CFP · 2352x1568px.
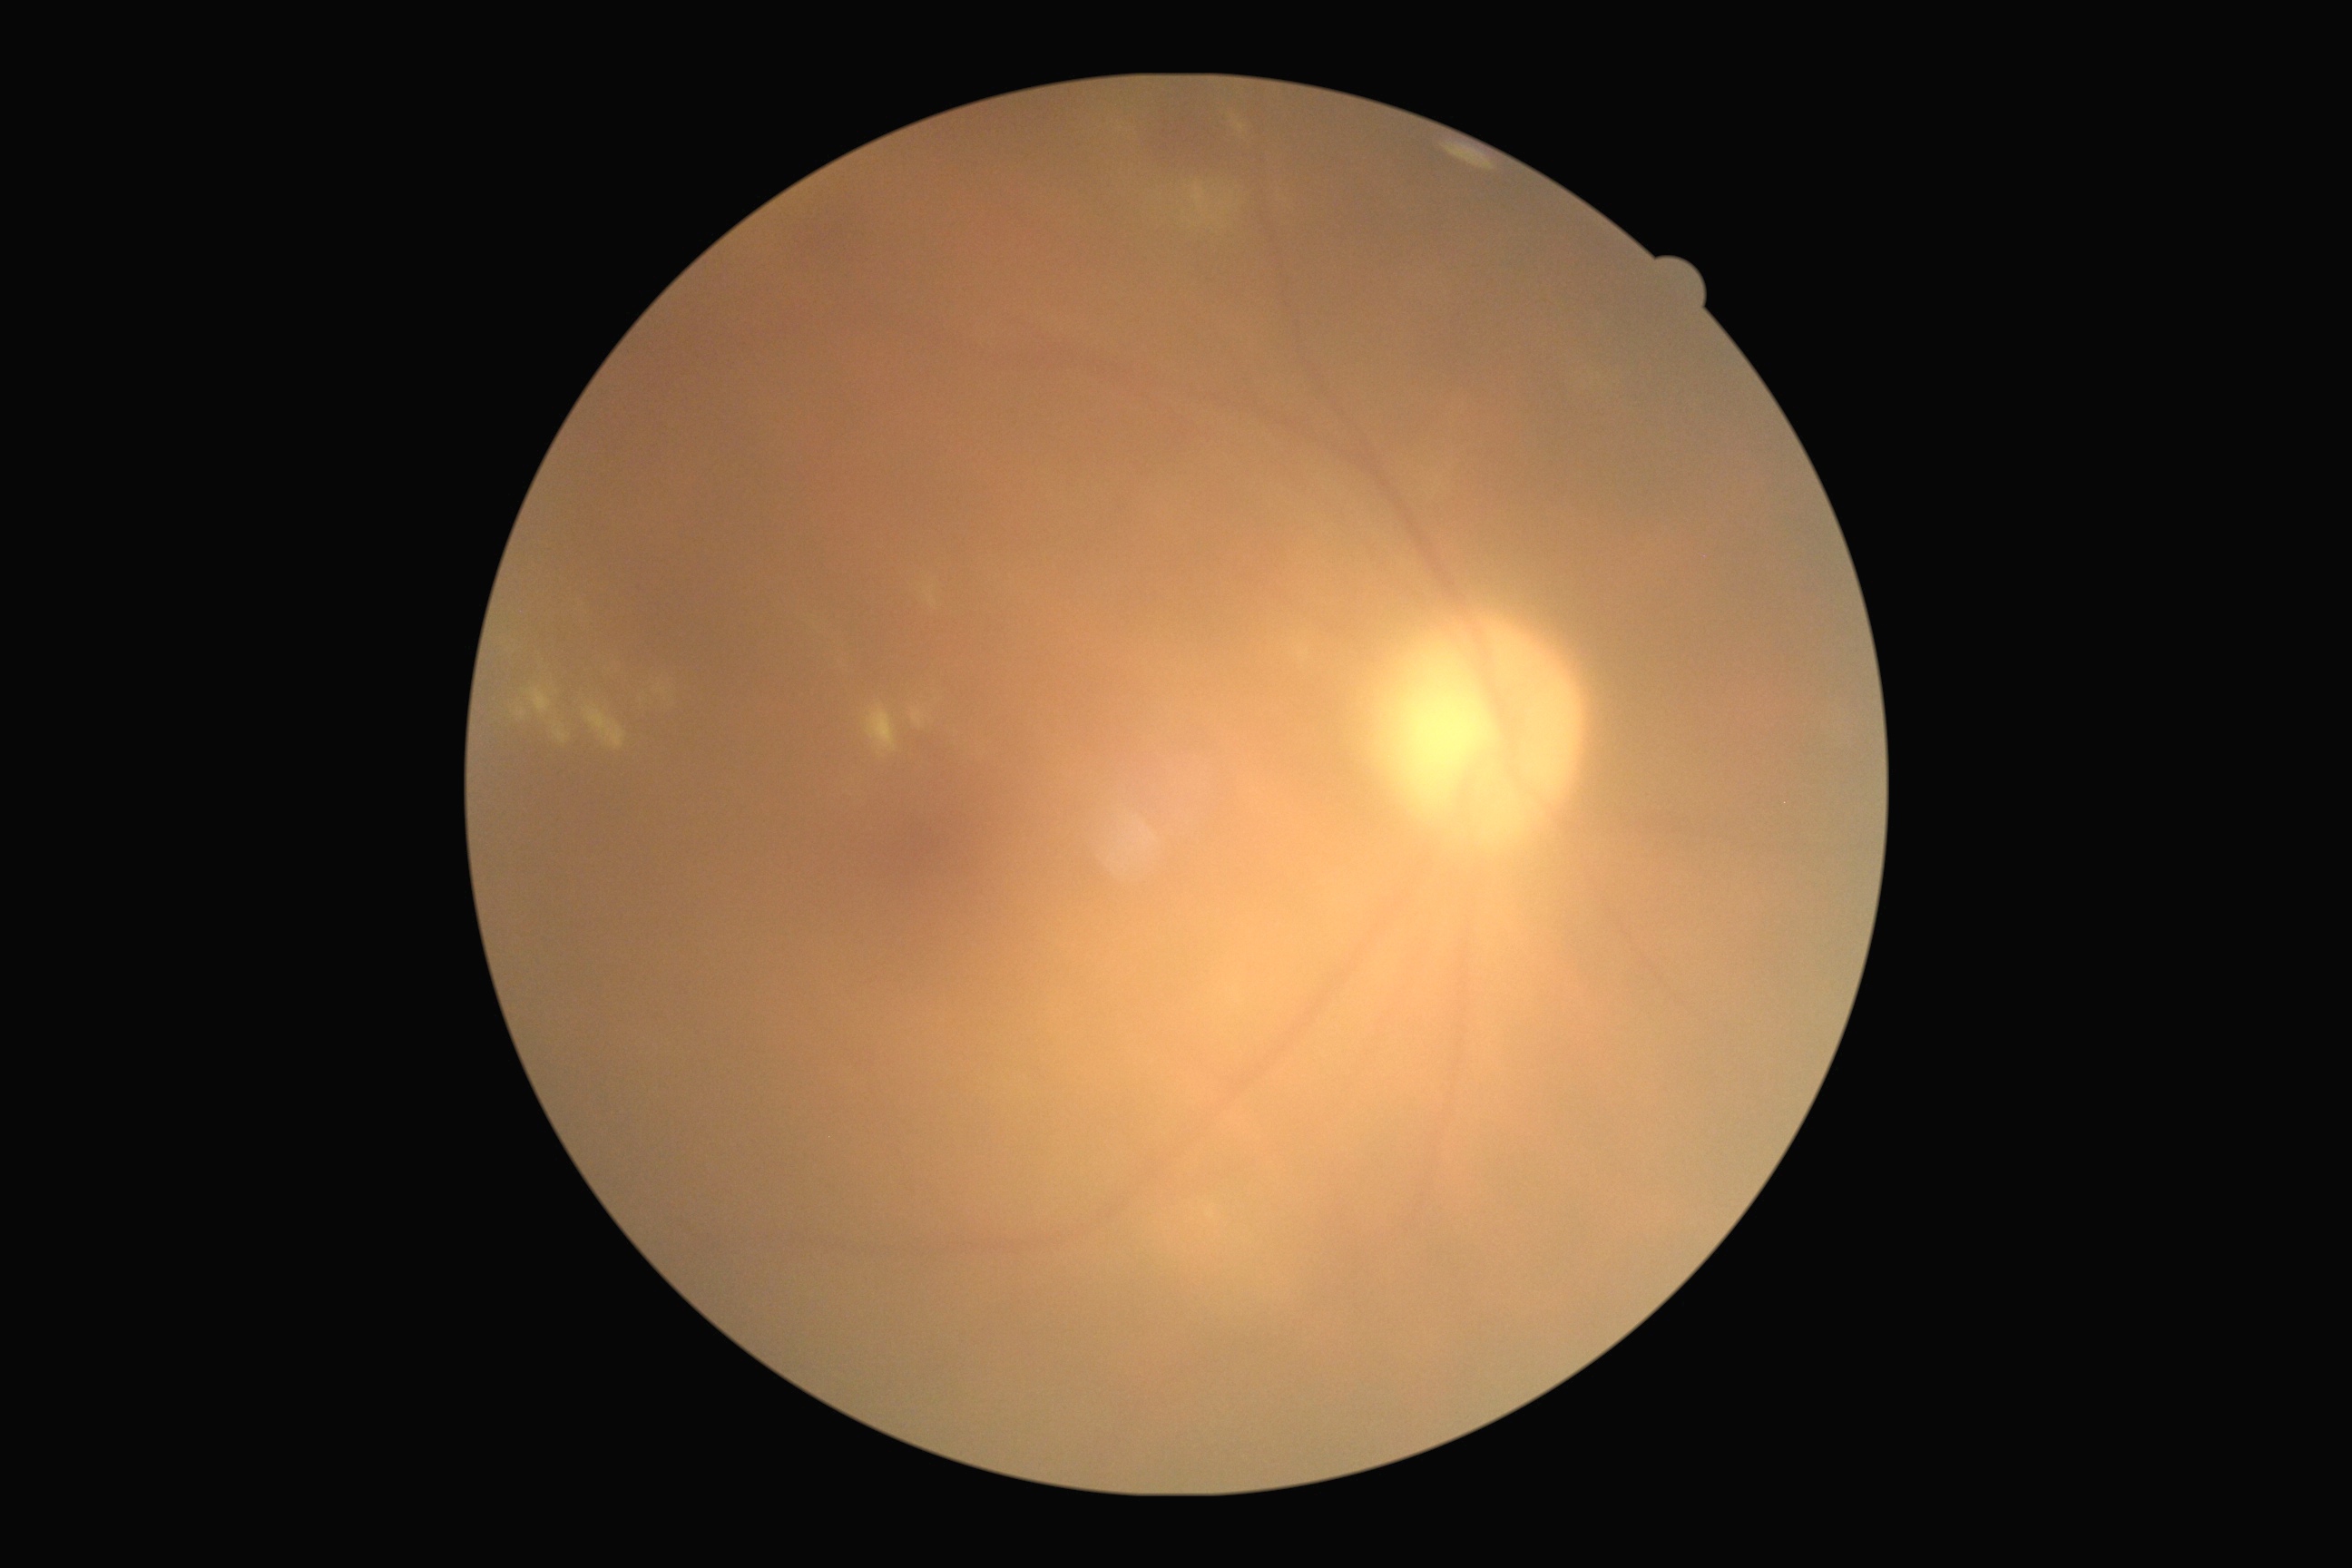

Diabetic retinopathy (DR) is grade 2 (moderate NPDR).